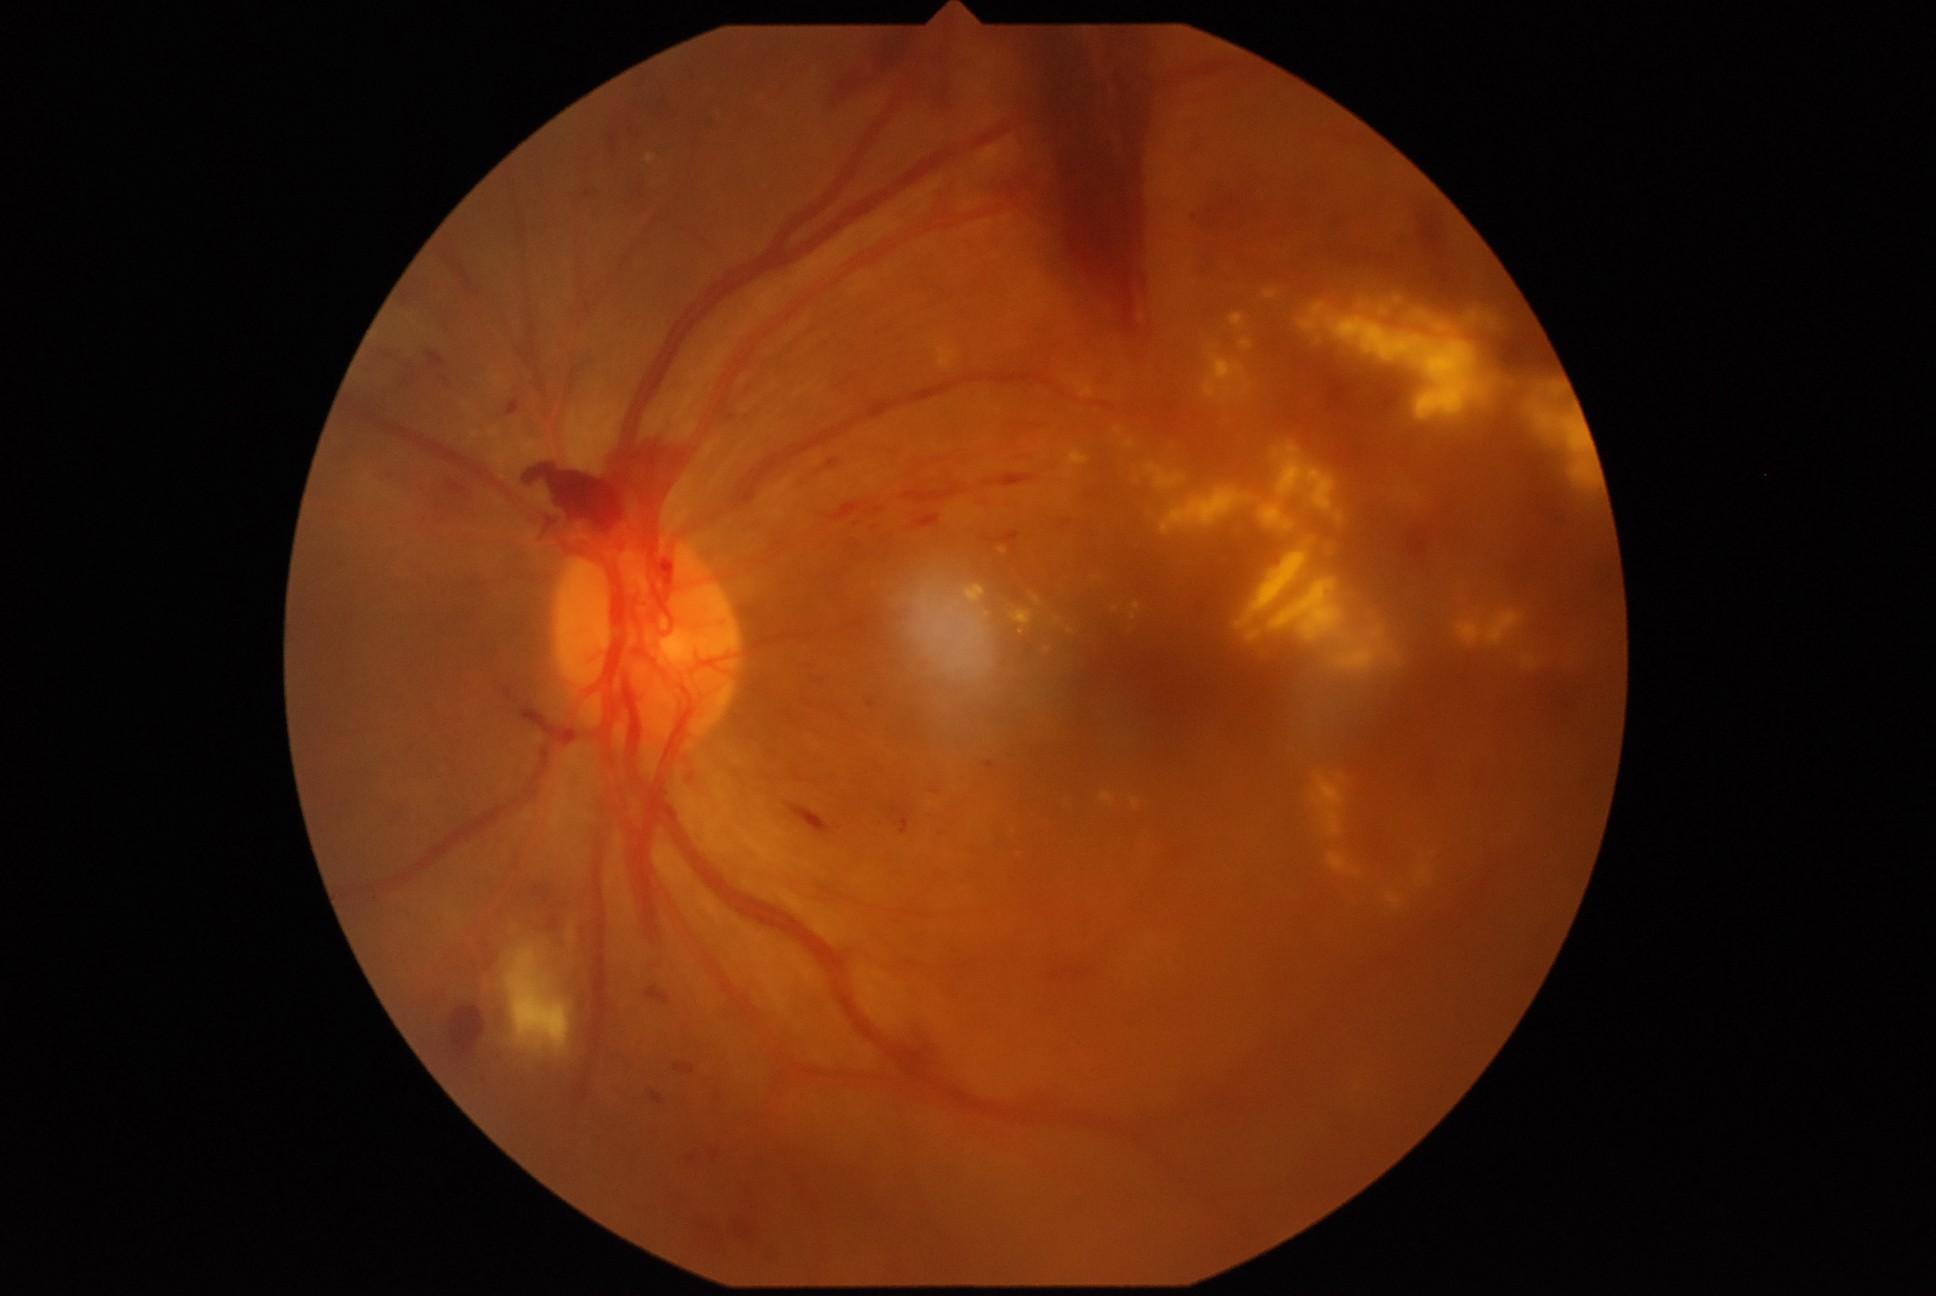

DR grade: PDR (4).